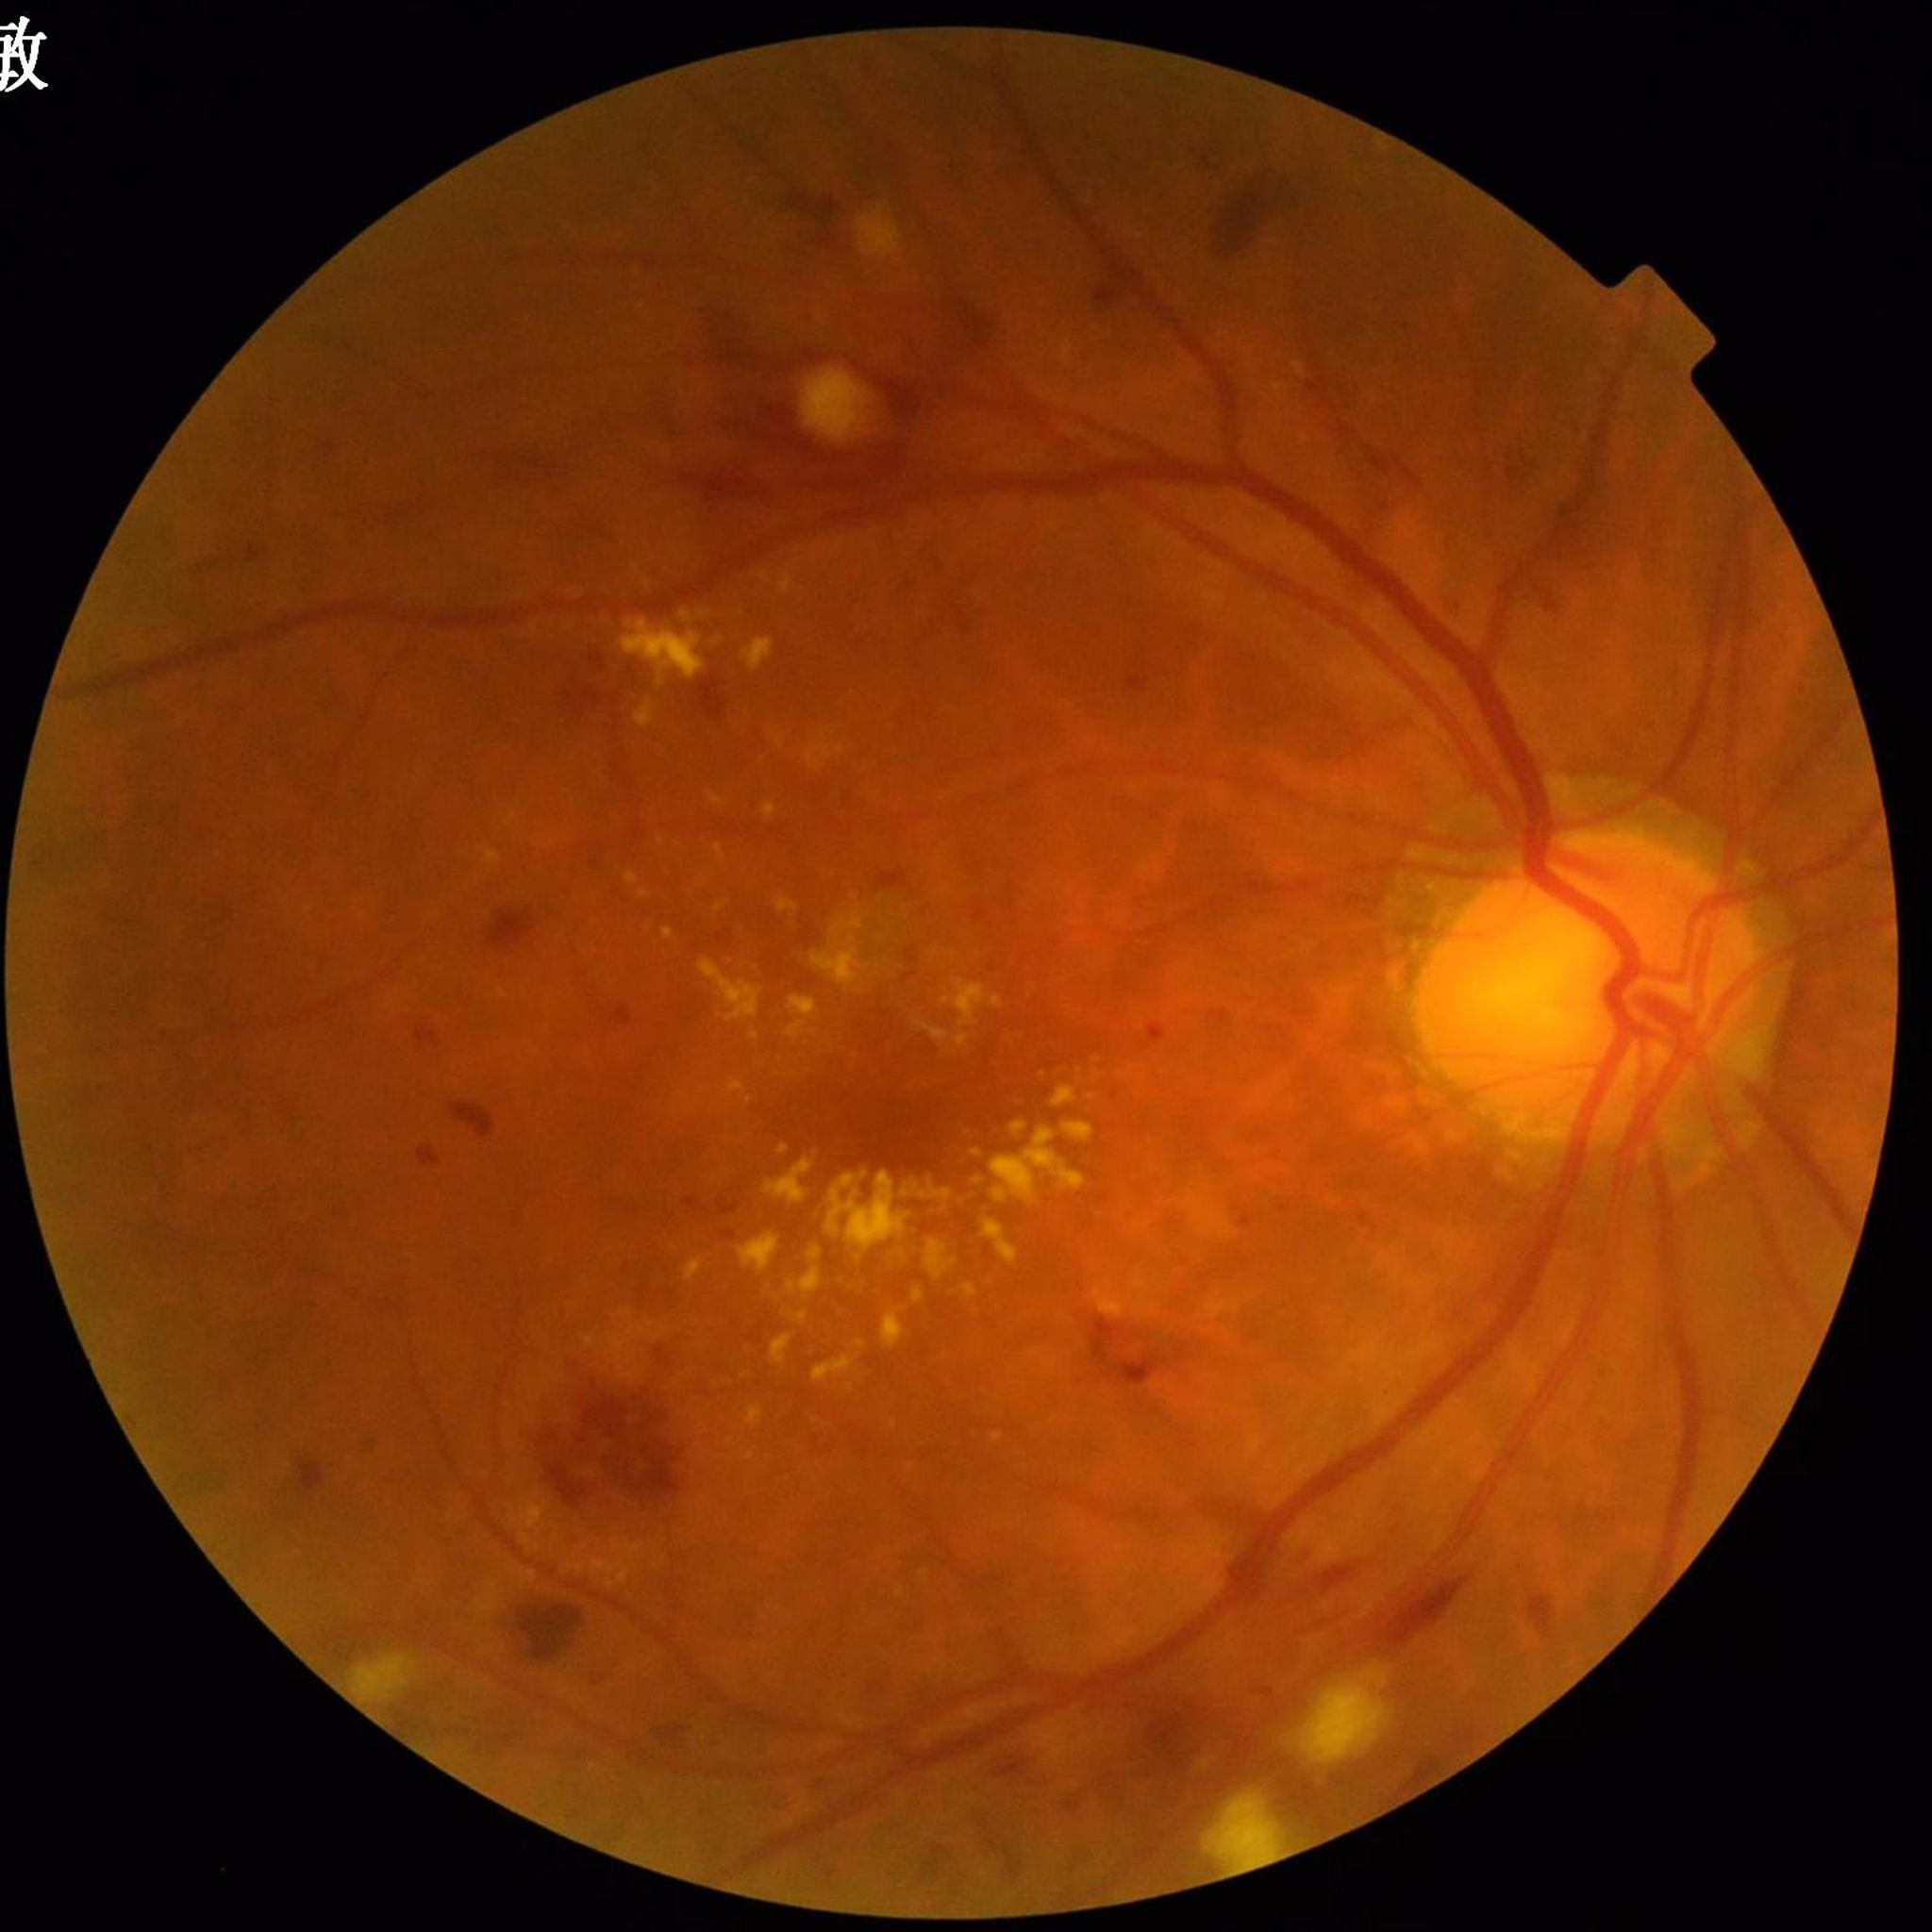

Diagnosed with DR.